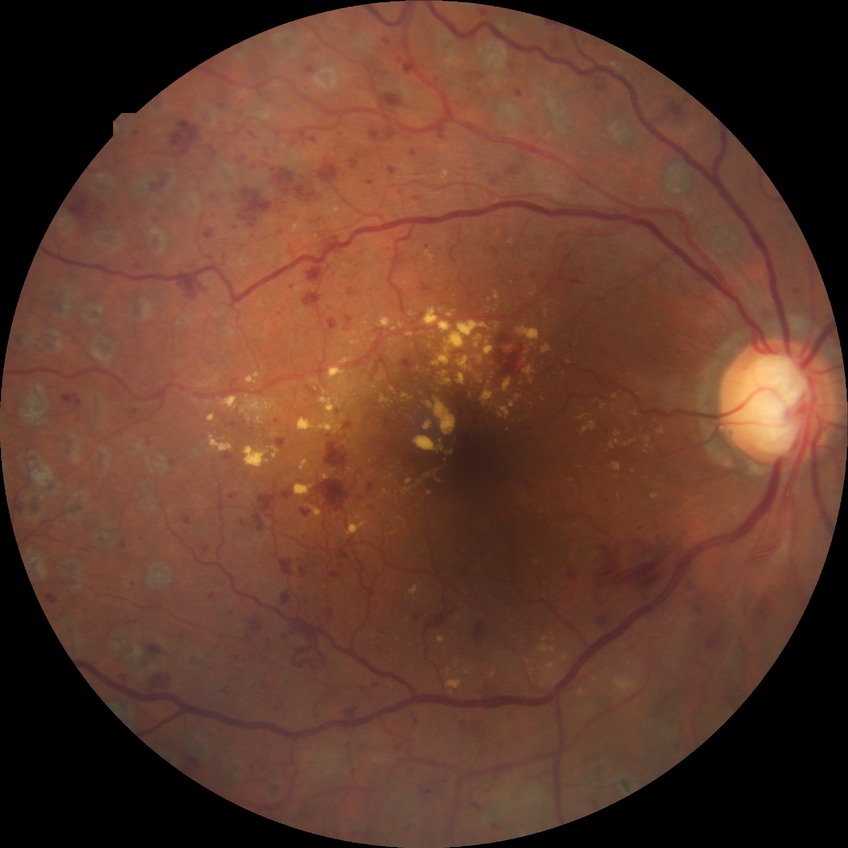
Diabetic retinopathy severity: proliferative diabetic retinopathy.